Posterior pole photograph. Nonmydriatic. 45 degree fundus photograph. Modified Davis grading — 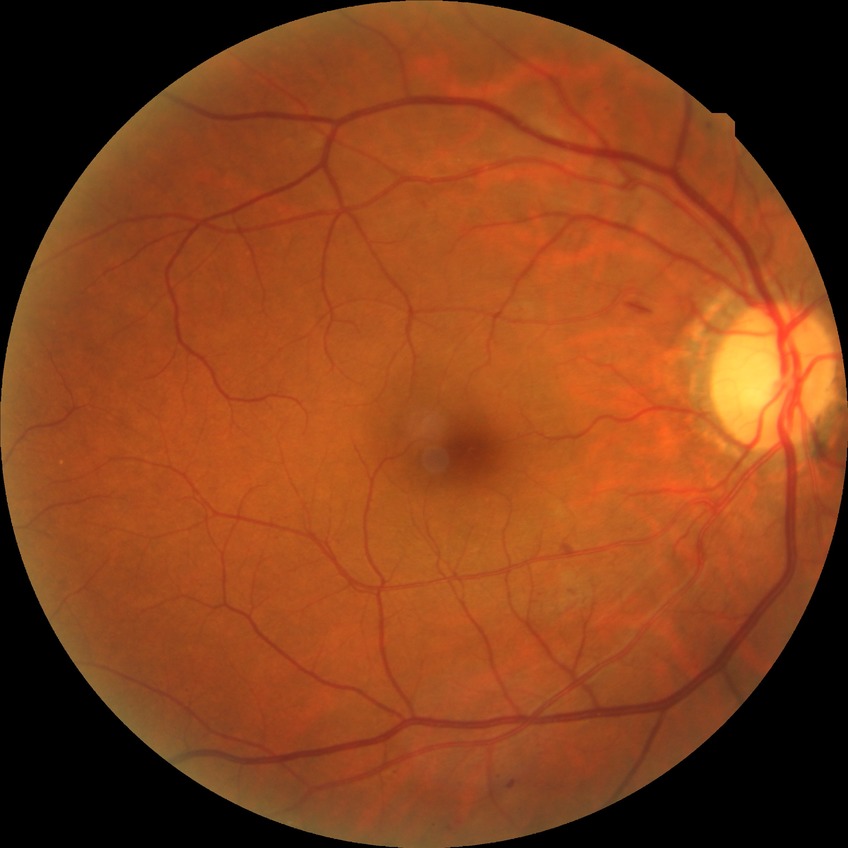 Diabetic retinopathy stage is simple diabetic retinopathy.